Mydriatic (tropicamide phenylephrine 1.0%), 50-degree field of view, acquired with a Topcon TRC-NW8:
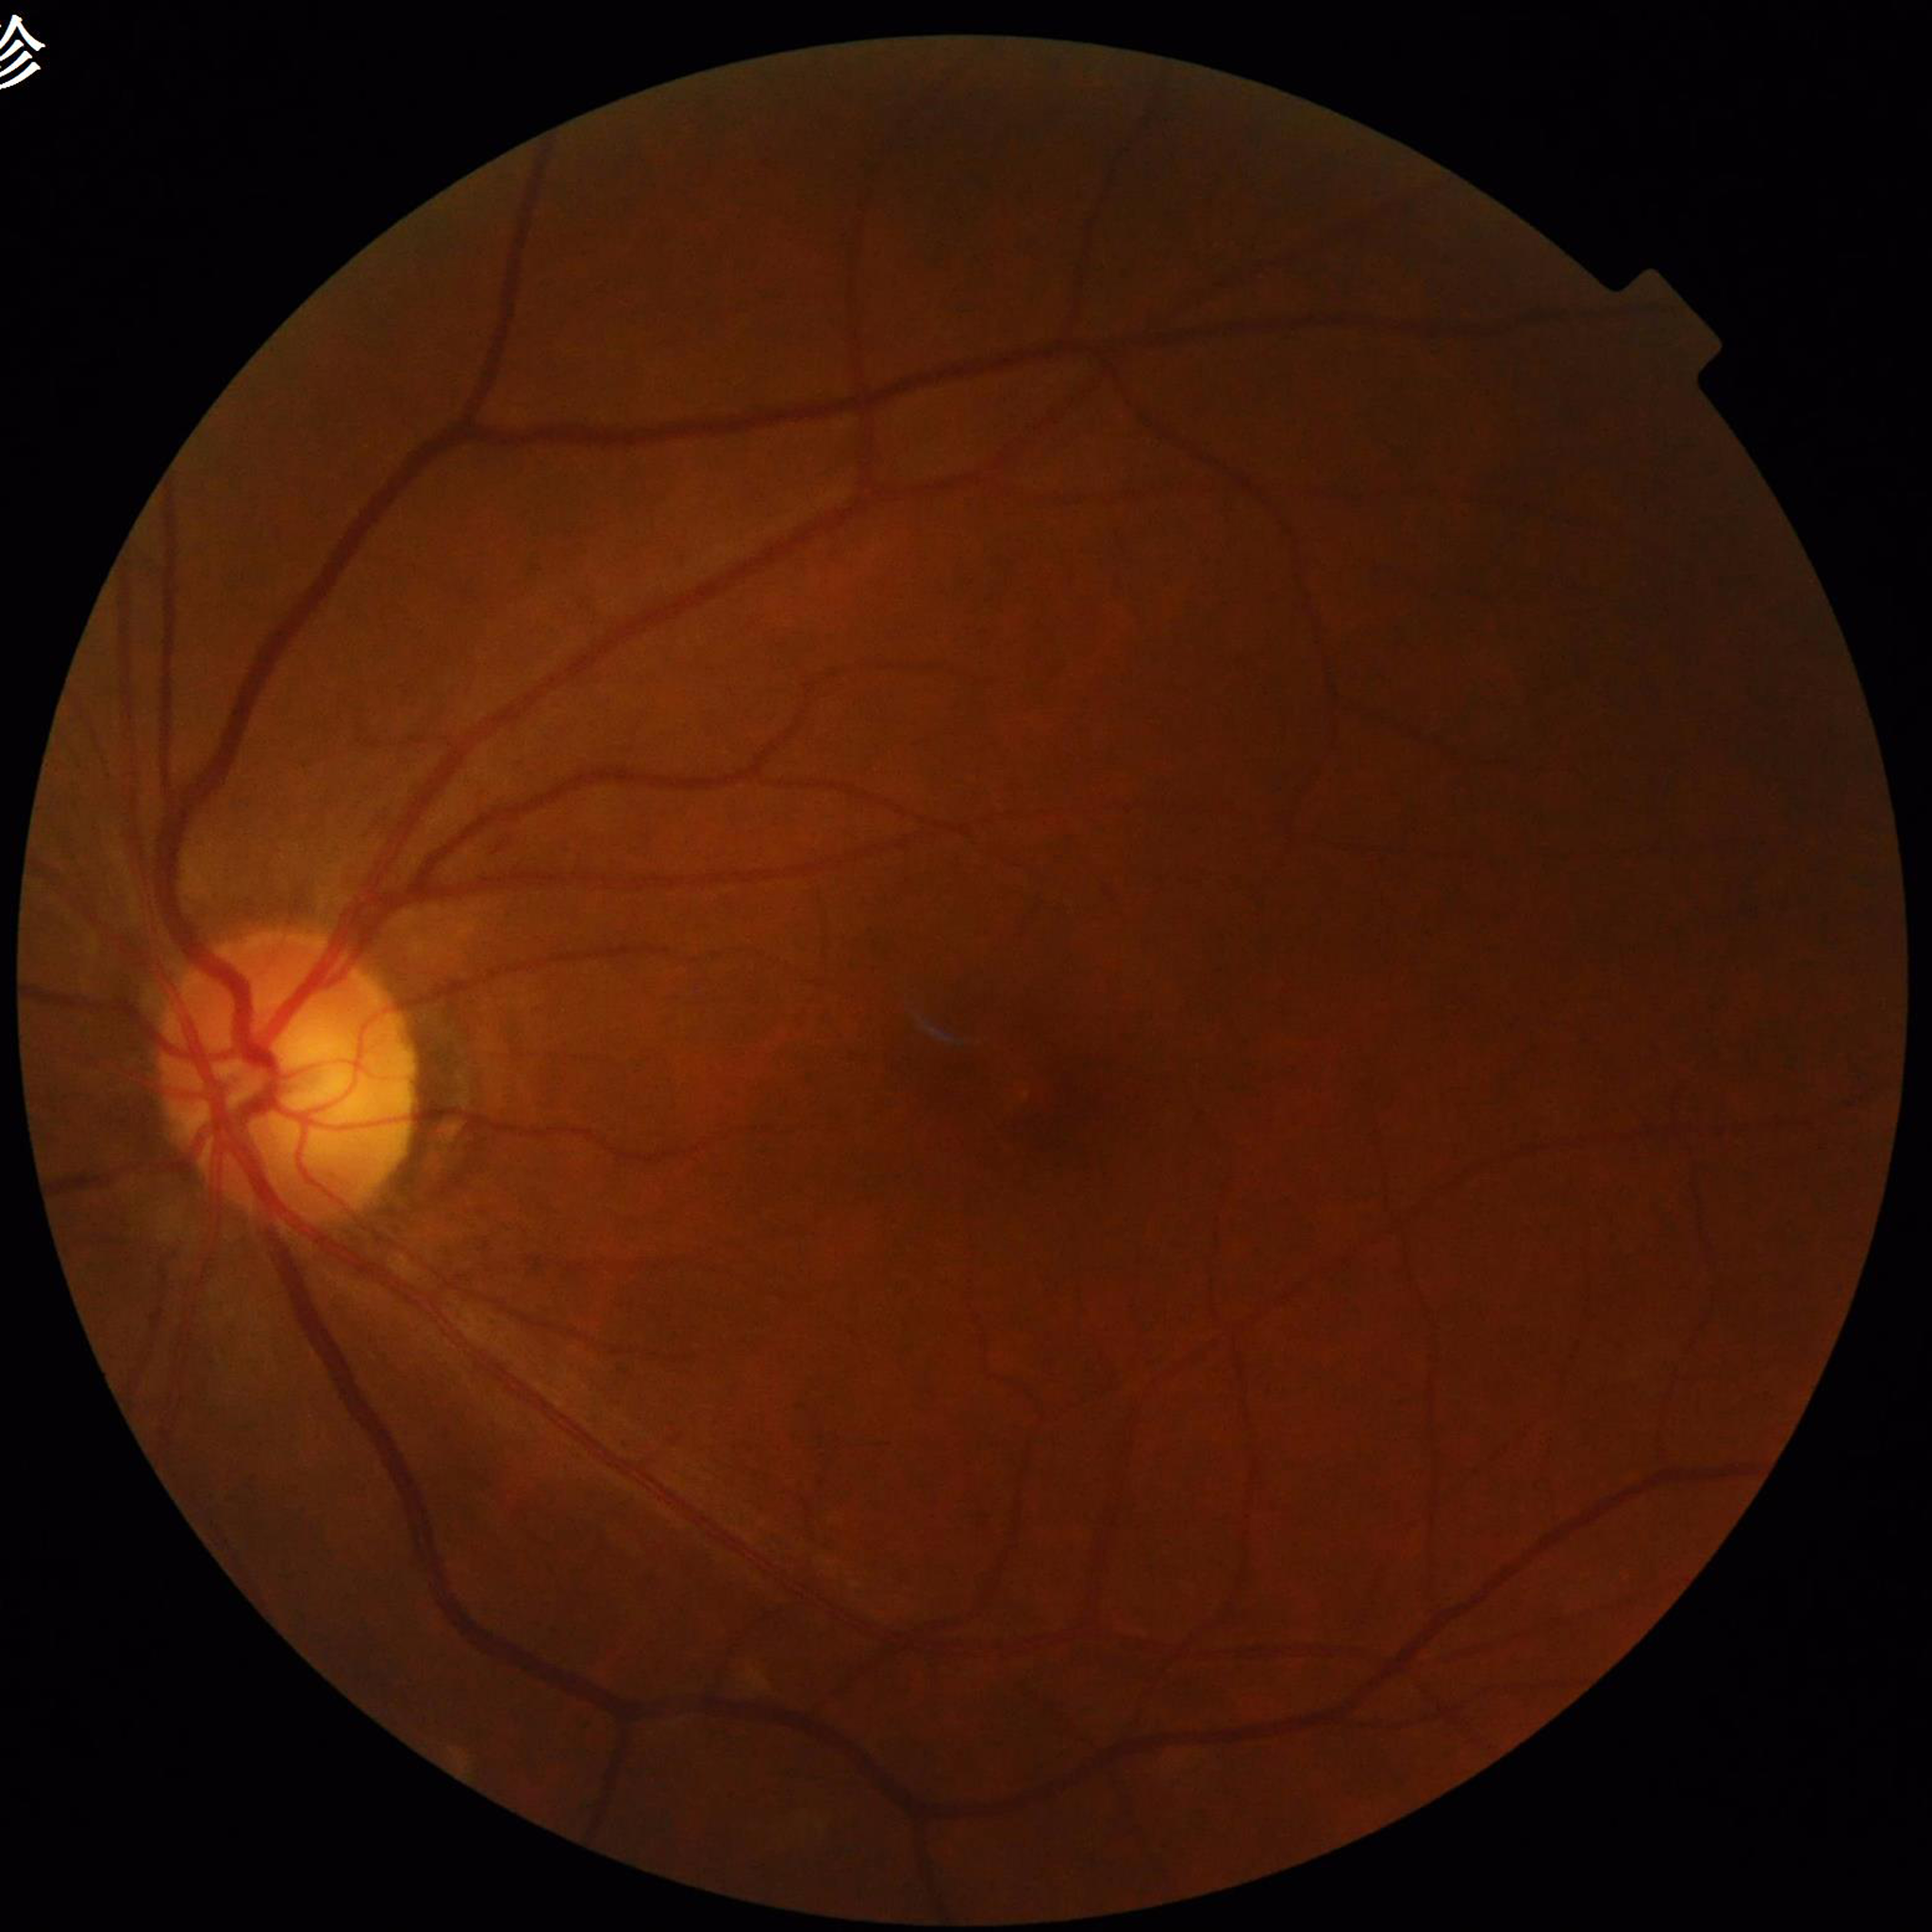
Quality assessment: adequate. Fundus image of an eye with diabetic retinopathy (DR).